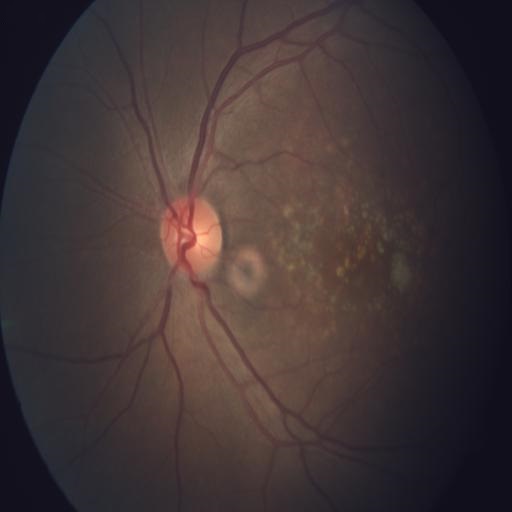 Showing age-related macular degeneration.